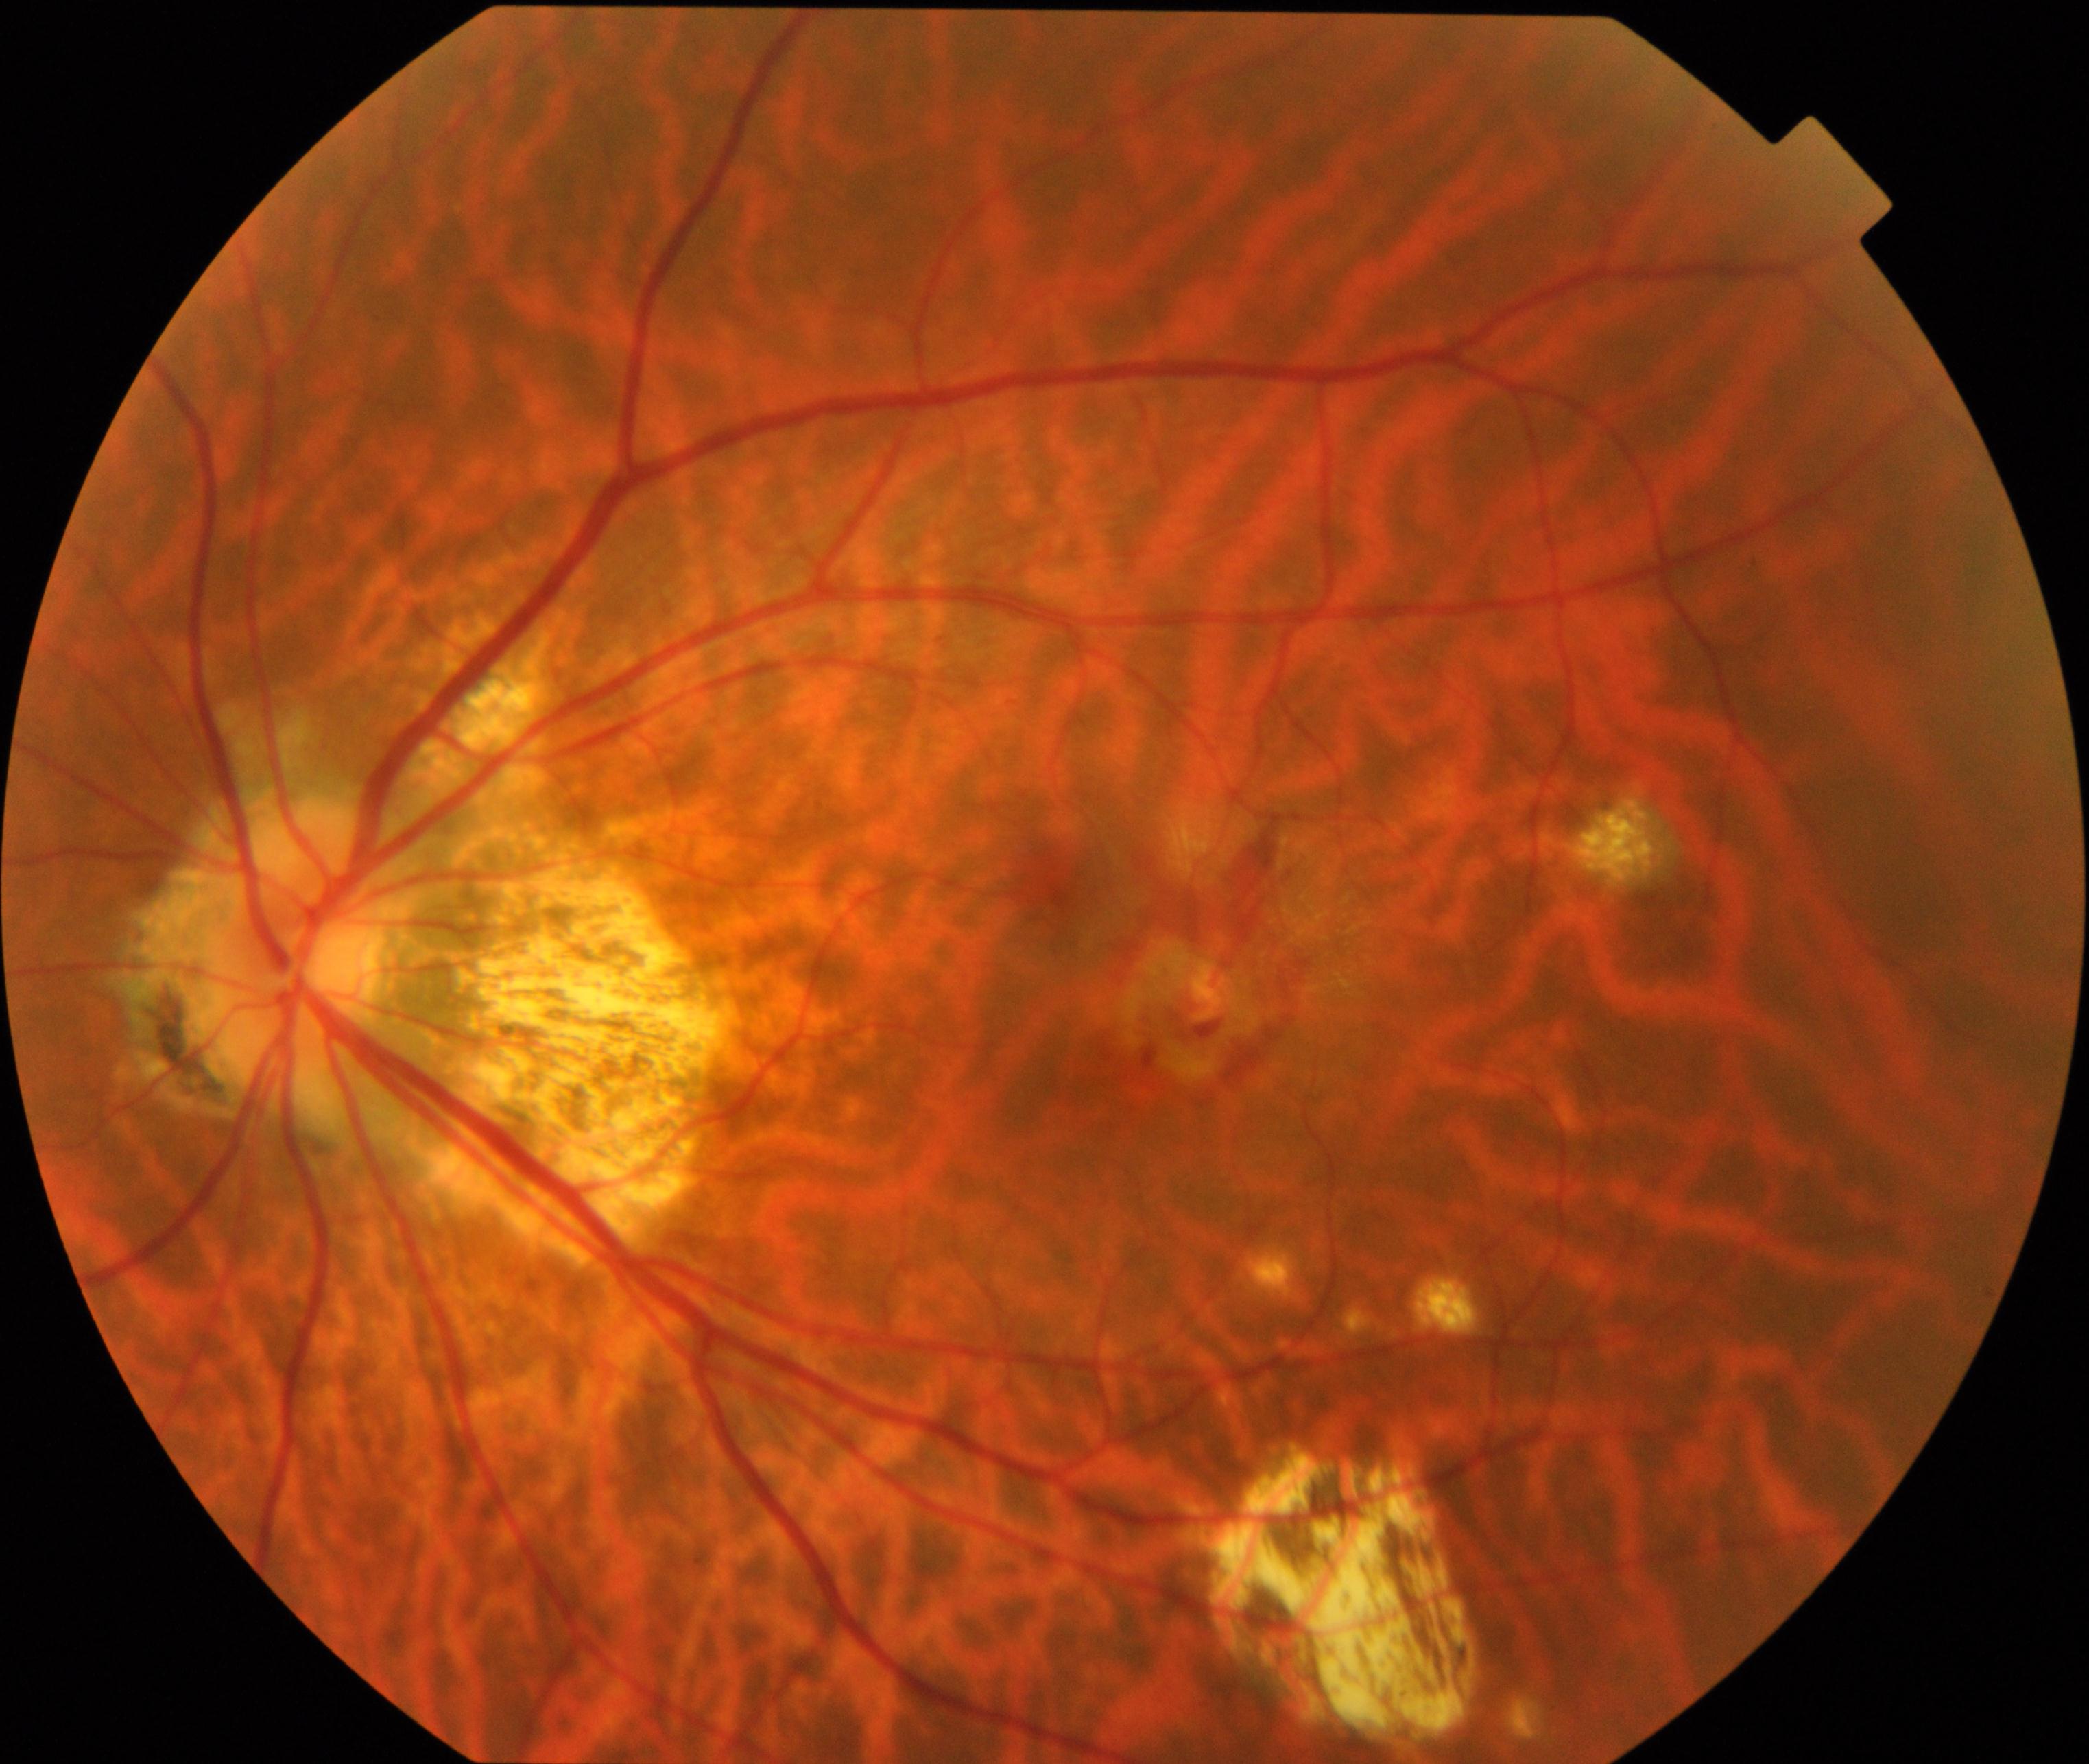

Fundus image consistent with pathological myopia.